Color fundus image
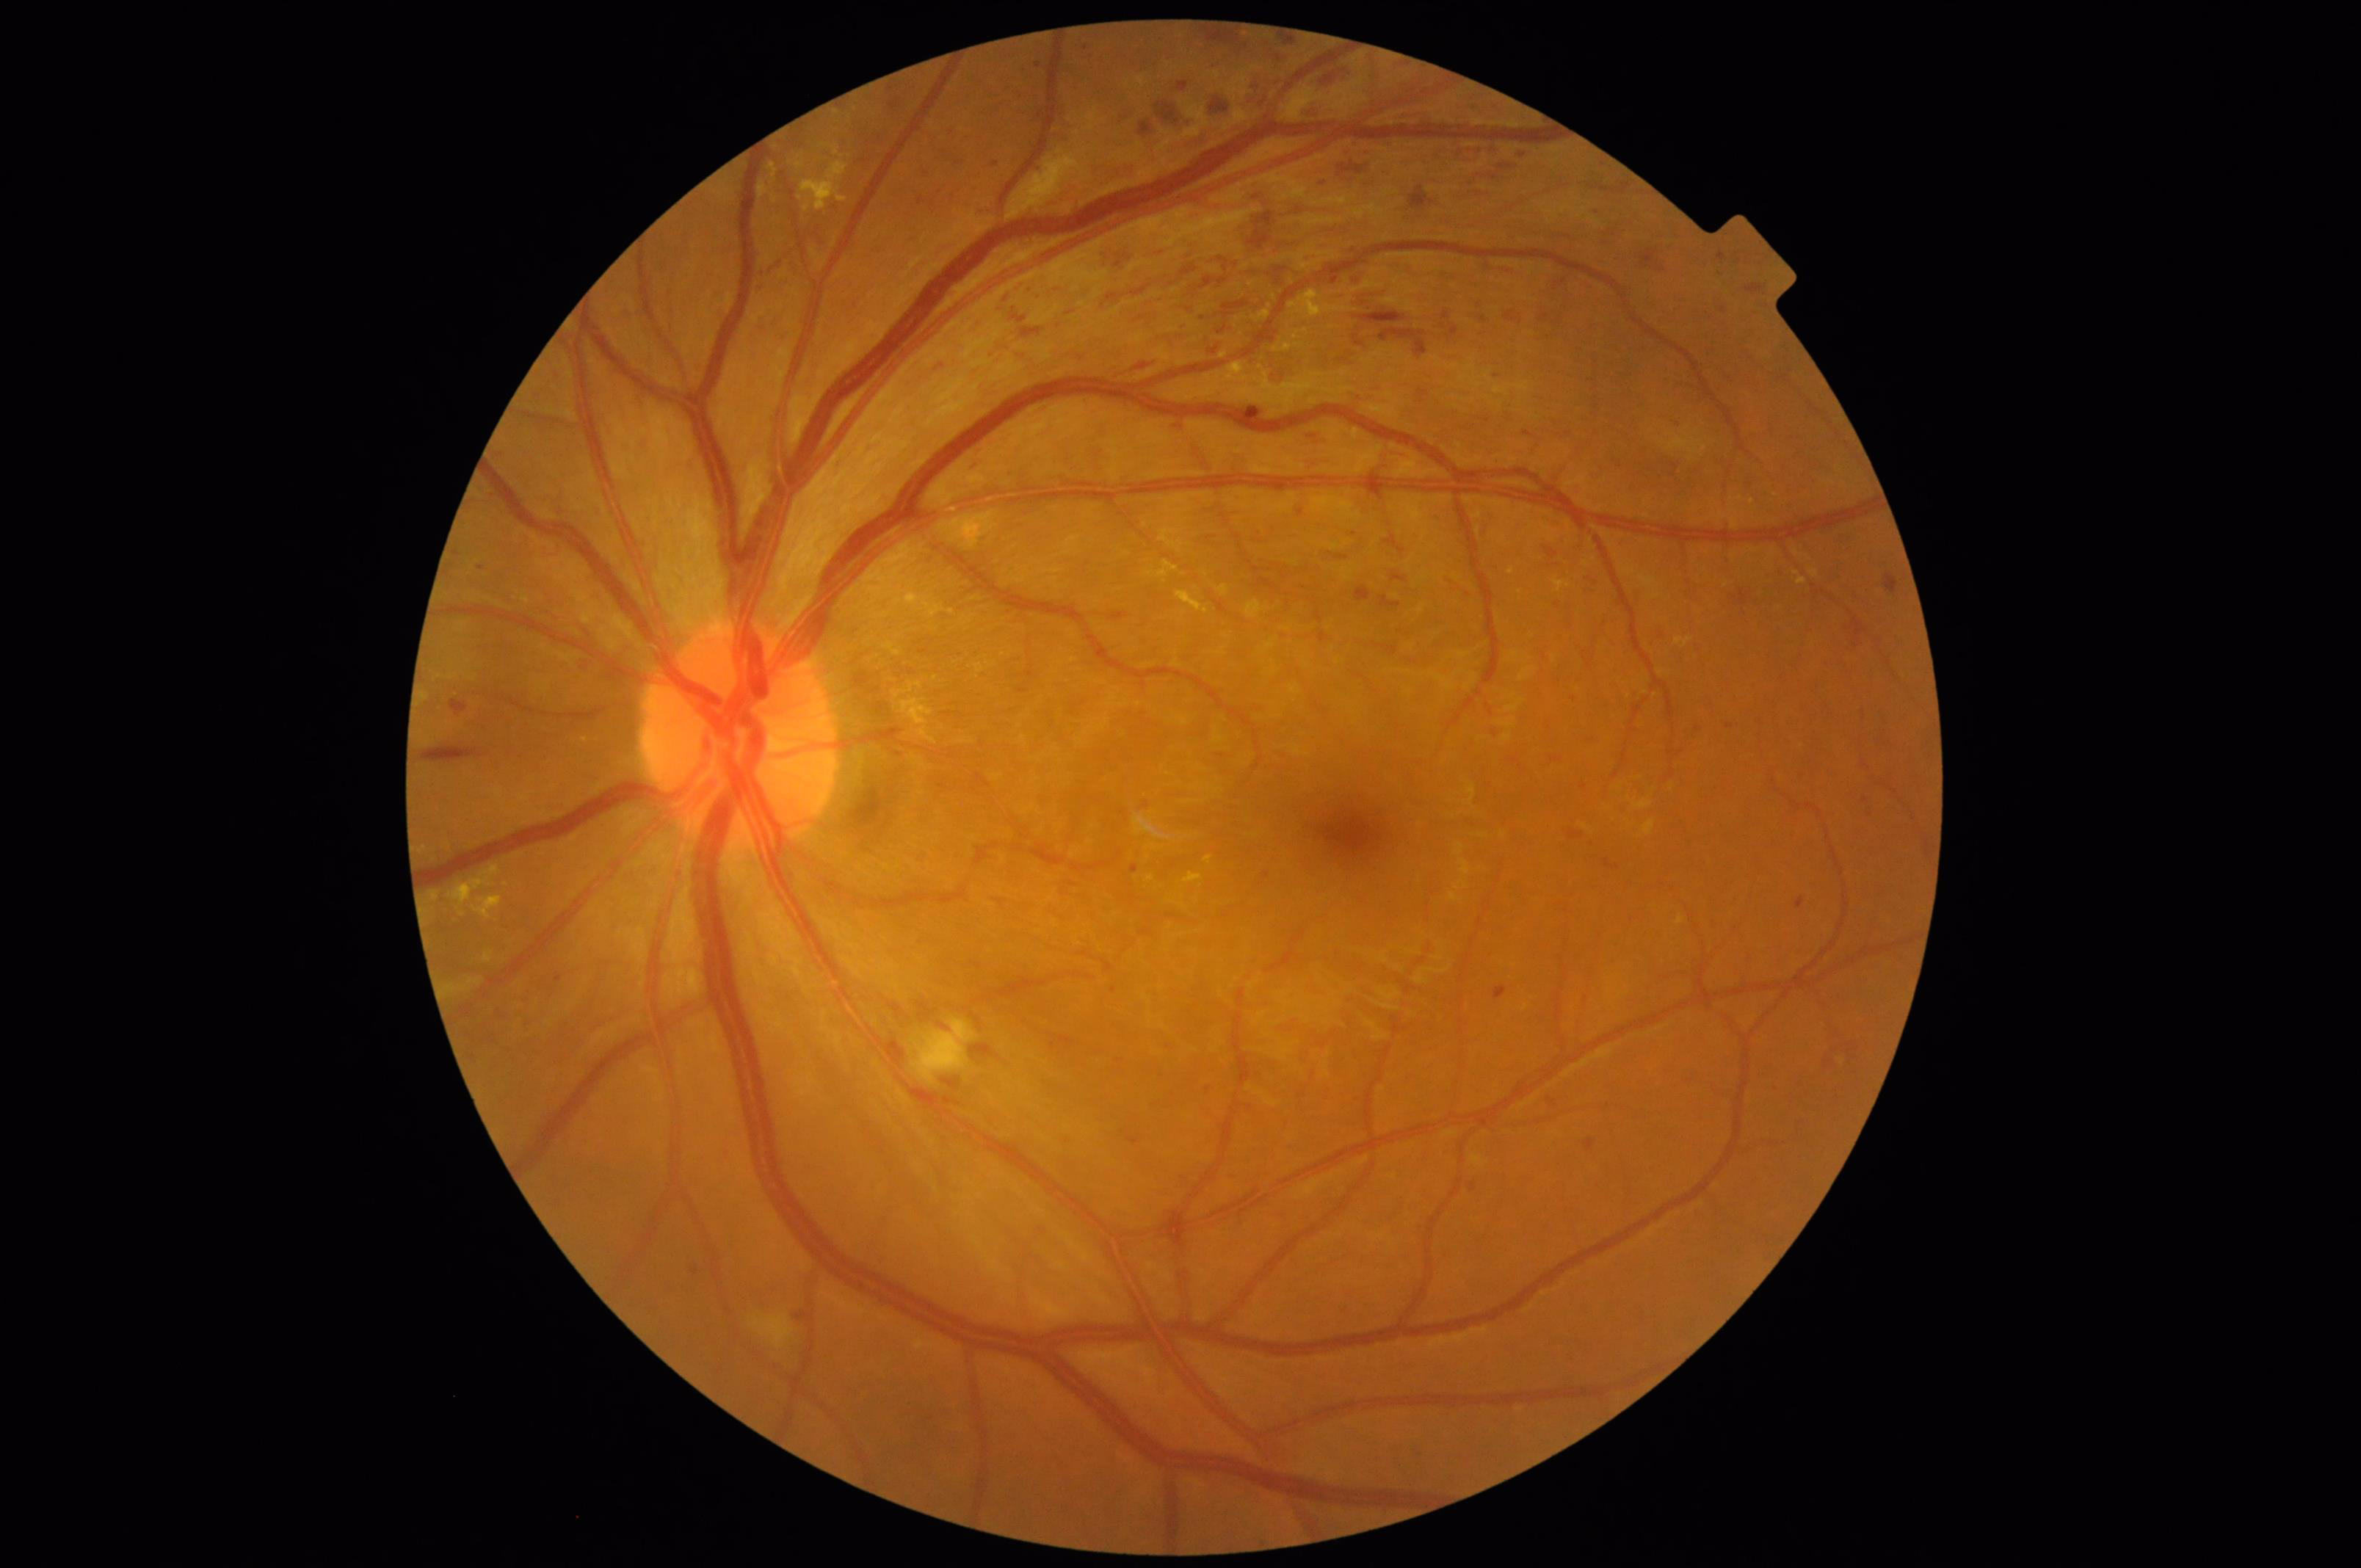 Overall image quality is good. Image is sharp throughout the field. Good dynamic range.